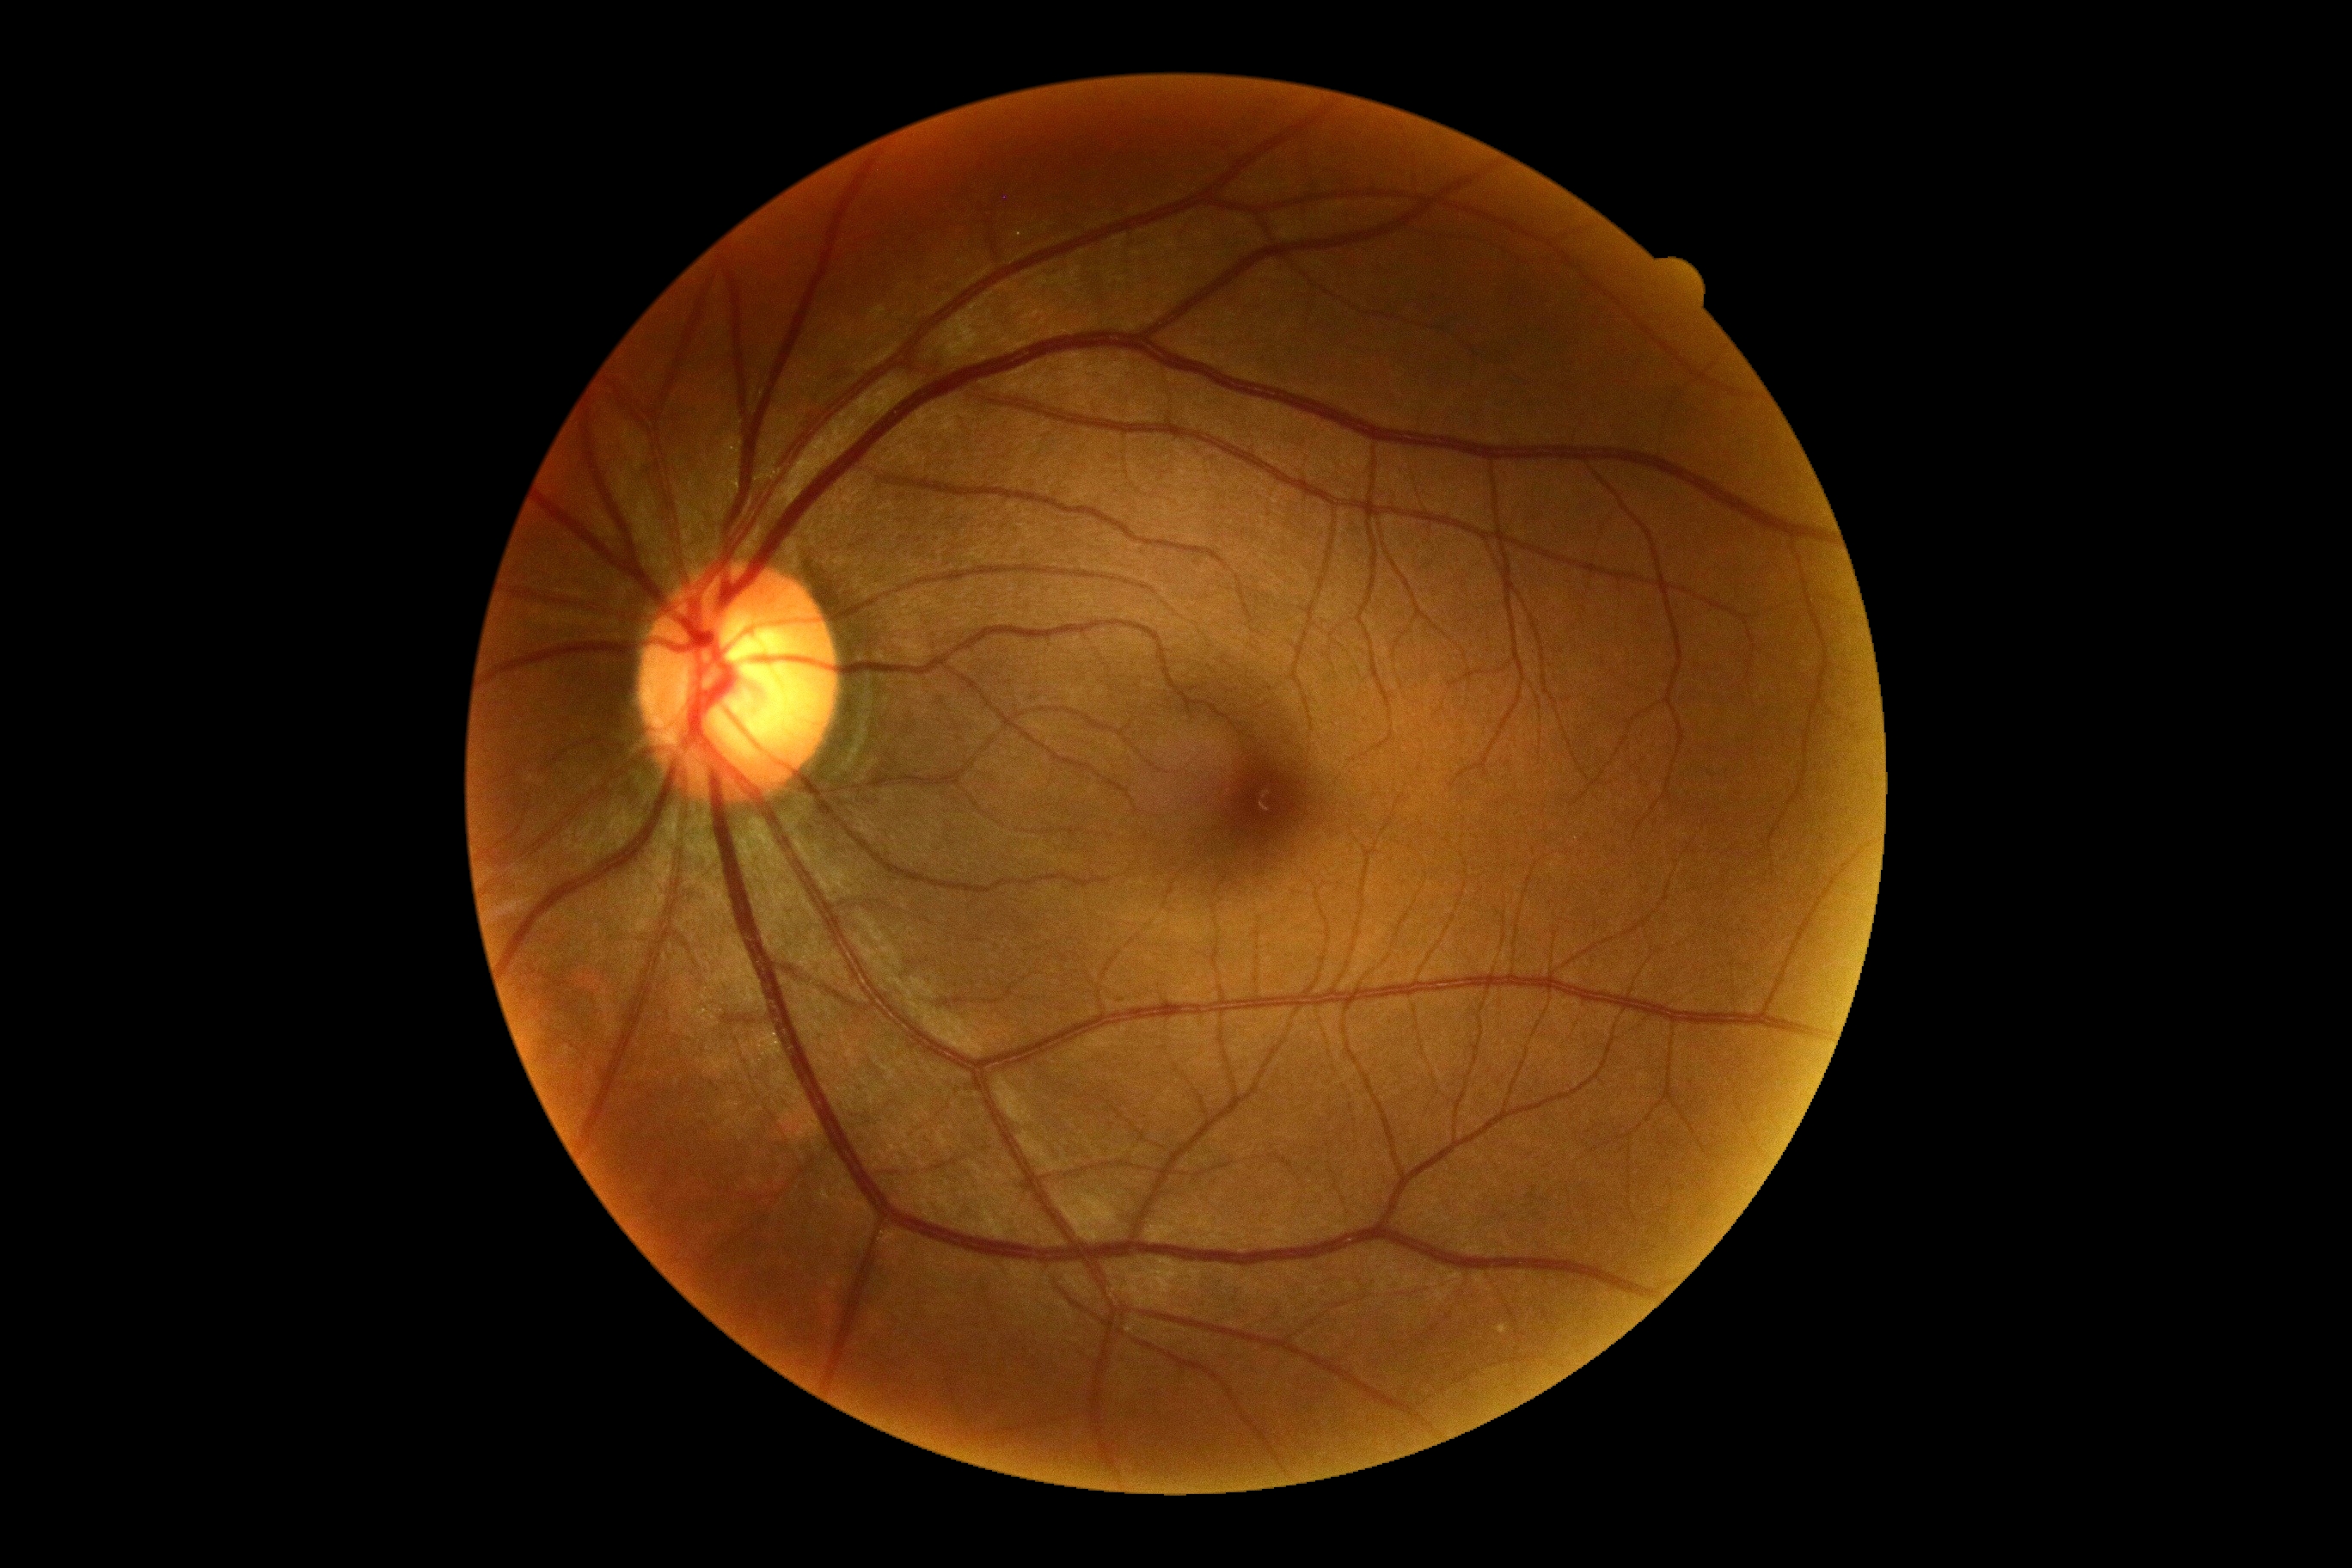

  dr_grade: grade 0 (no apparent retinopathy) — no visible signs of diabetic retinopathy
  dr_impression: no DR findings